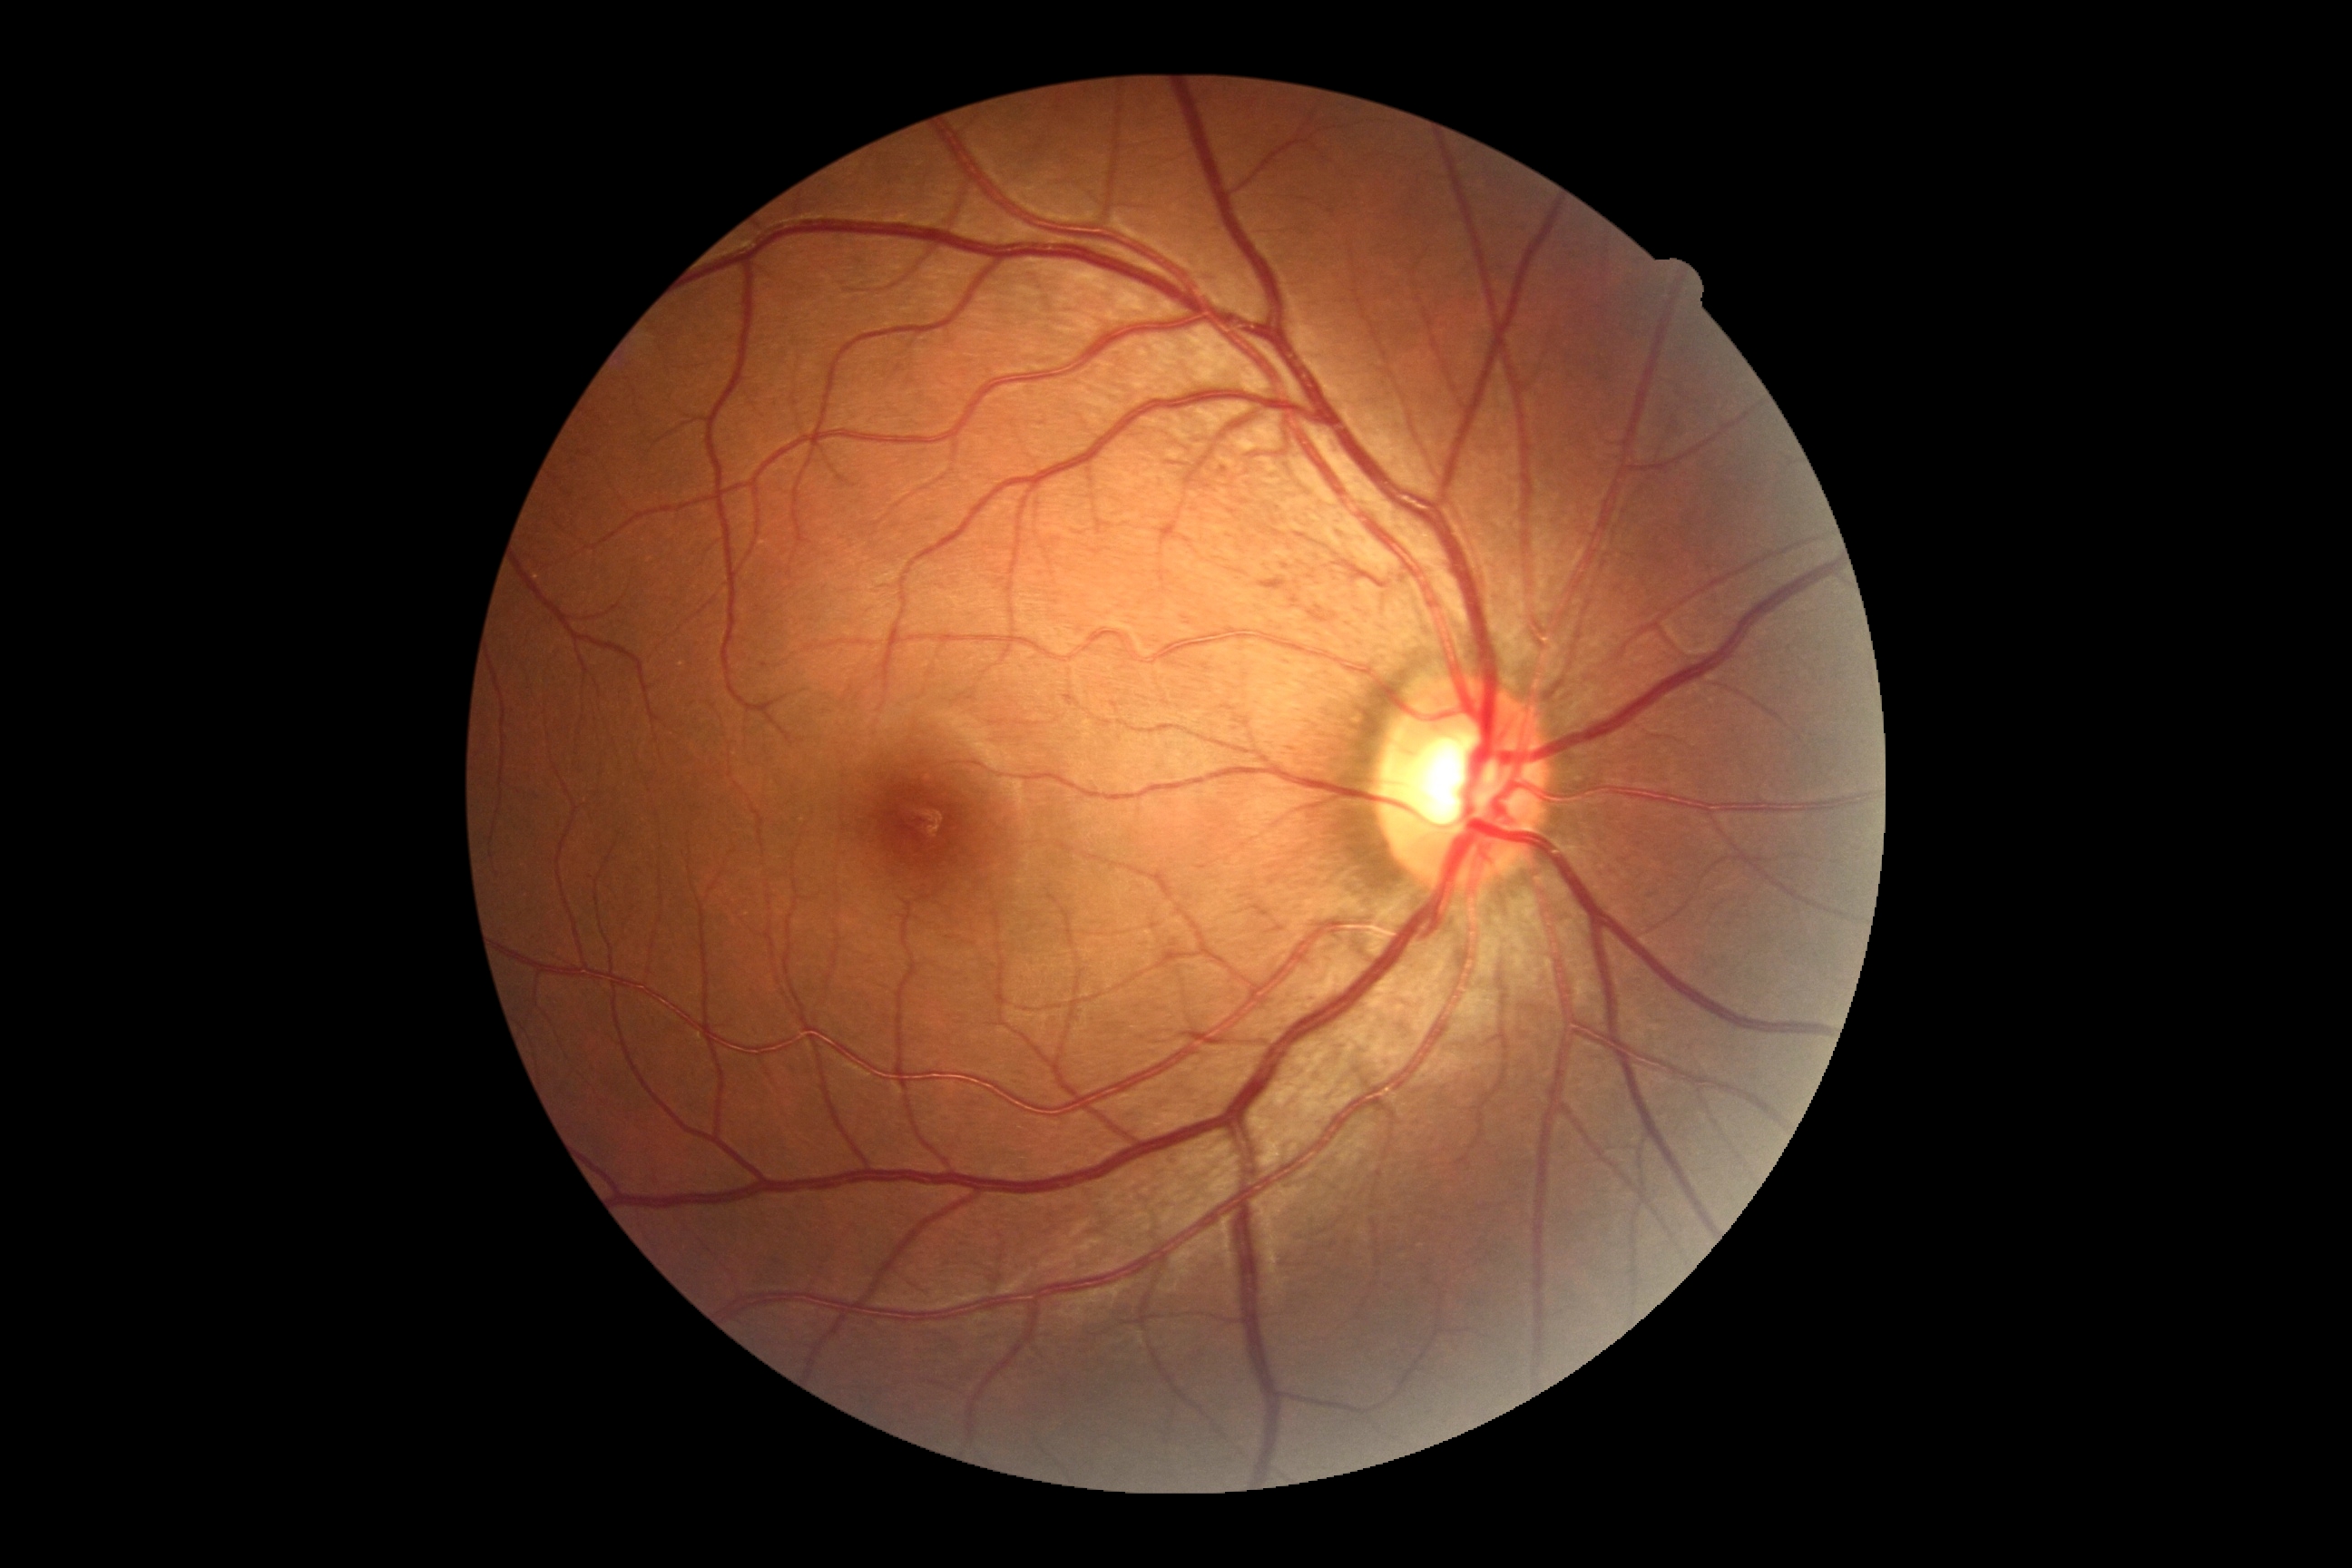
DR impression = no DR findings | diabetic retinopathy (DR) = no apparent diabetic retinopathy (grade 0).